Image size 2352x1568. 45° field of view. CFP — 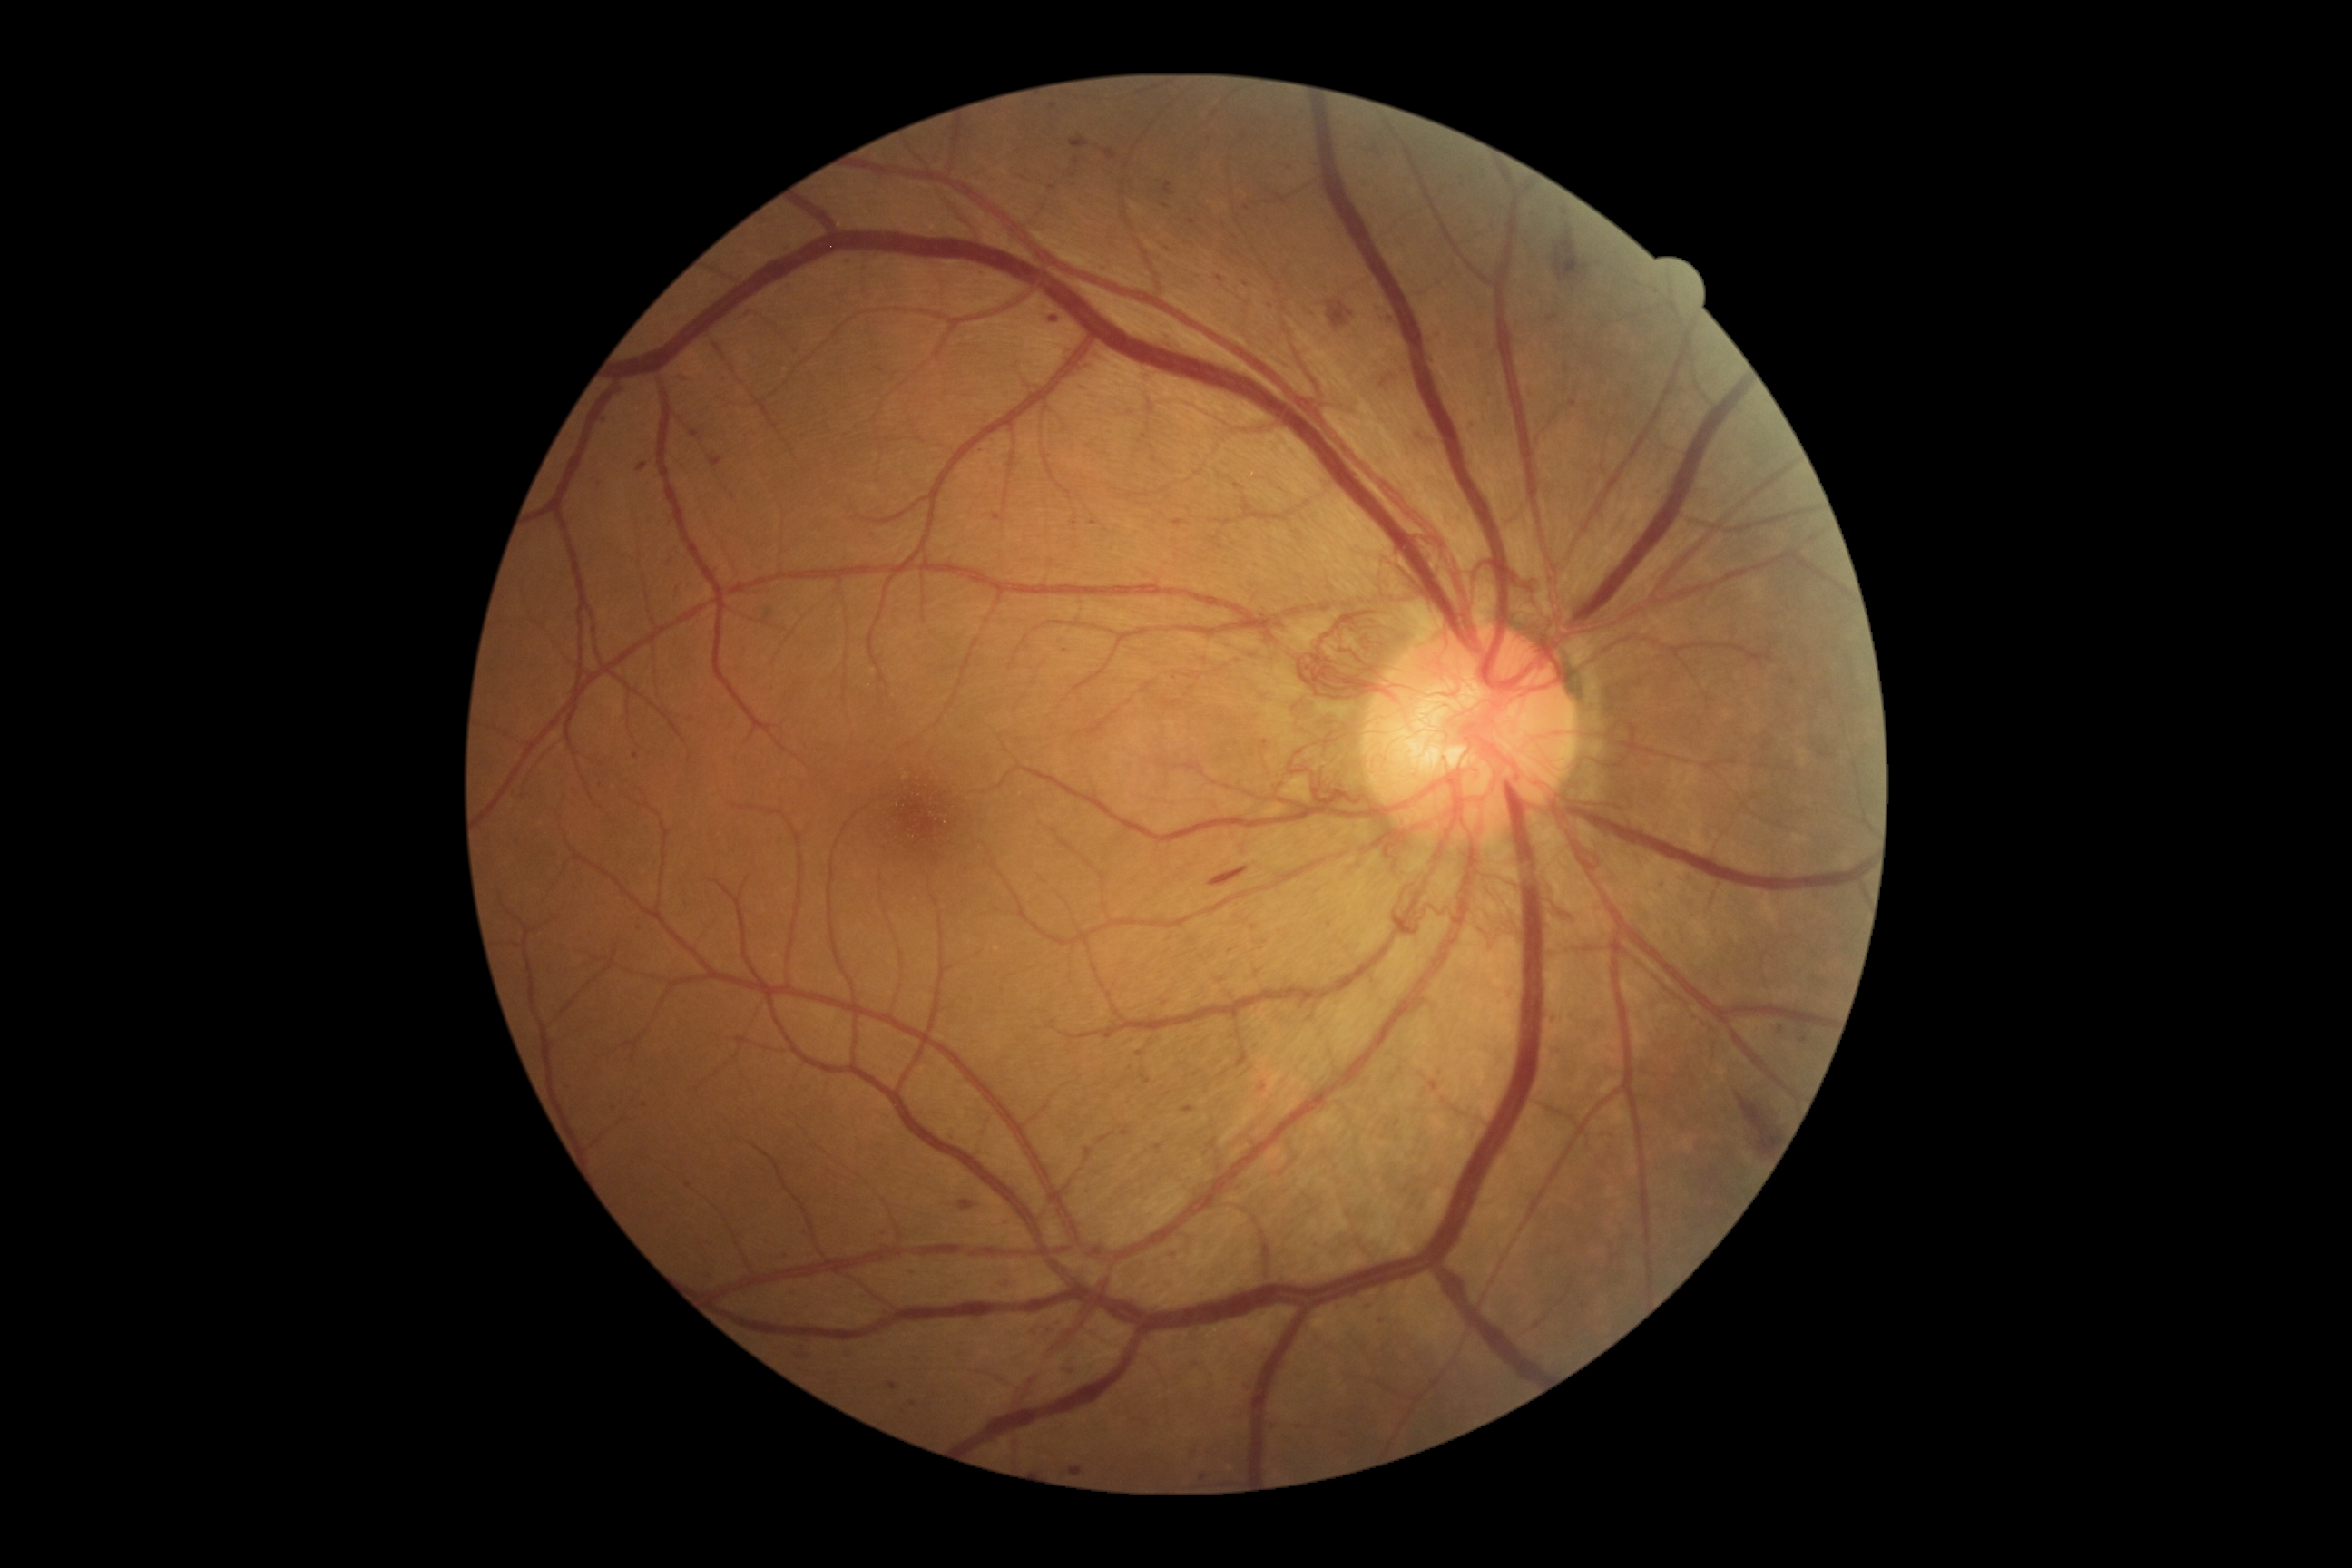
Retinopathy: grade 4.
Microaneurysms are present, including at bbox=[1217, 275, 1224, 284]; bbox=[607, 1106, 618, 1112]; bbox=[1182, 1106, 1193, 1115]; bbox=[1050, 317, 1059, 322]; bbox=[1603, 409, 1611, 413]; bbox=[598, 416, 607, 424]; bbox=[1003, 1220, 1010, 1228]; bbox=[1433, 357, 1438, 366]; bbox=[790, 280, 798, 286]; bbox=[1055, 1317, 1063, 1322].
Microaneurysms (small, approximate centers) near 1070, 1370; 622, 392; 1443, 336; 1237, 486; 1193, 1361; 1781, 1031; 1168, 249; 1566, 212; 1167, 206.